1240x1240px · infant wide-field retinal image · acquired on the Phoenix ICON:
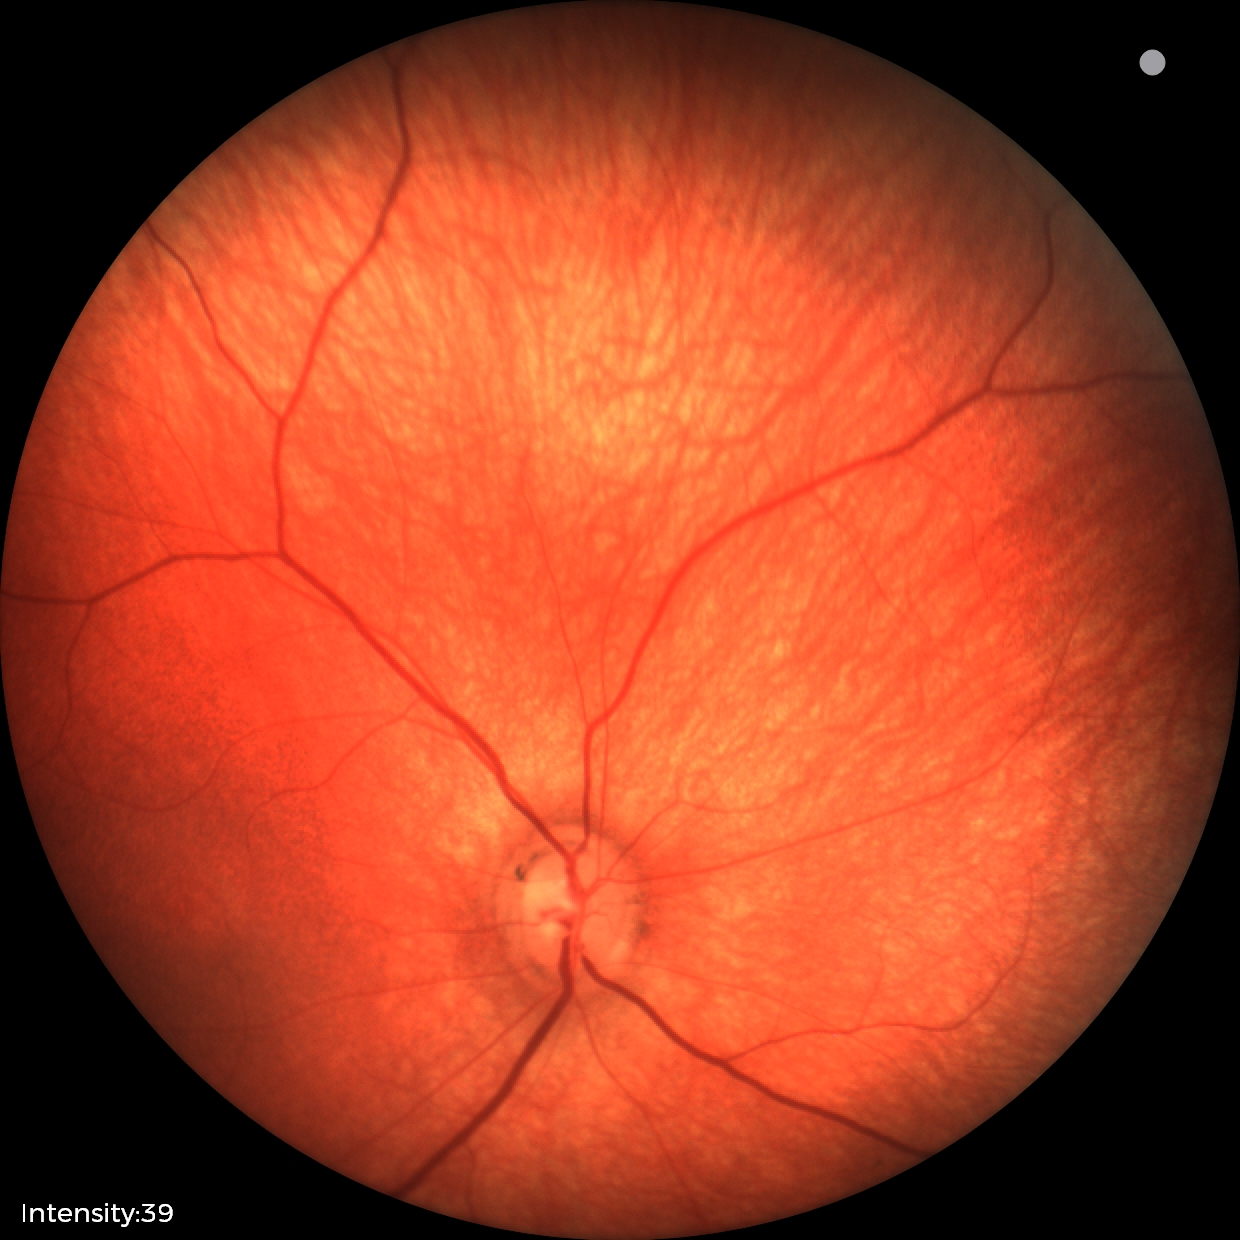 Q: What was the screening finding?
A: physiological retinal finding